NIDEK AFC-230 — 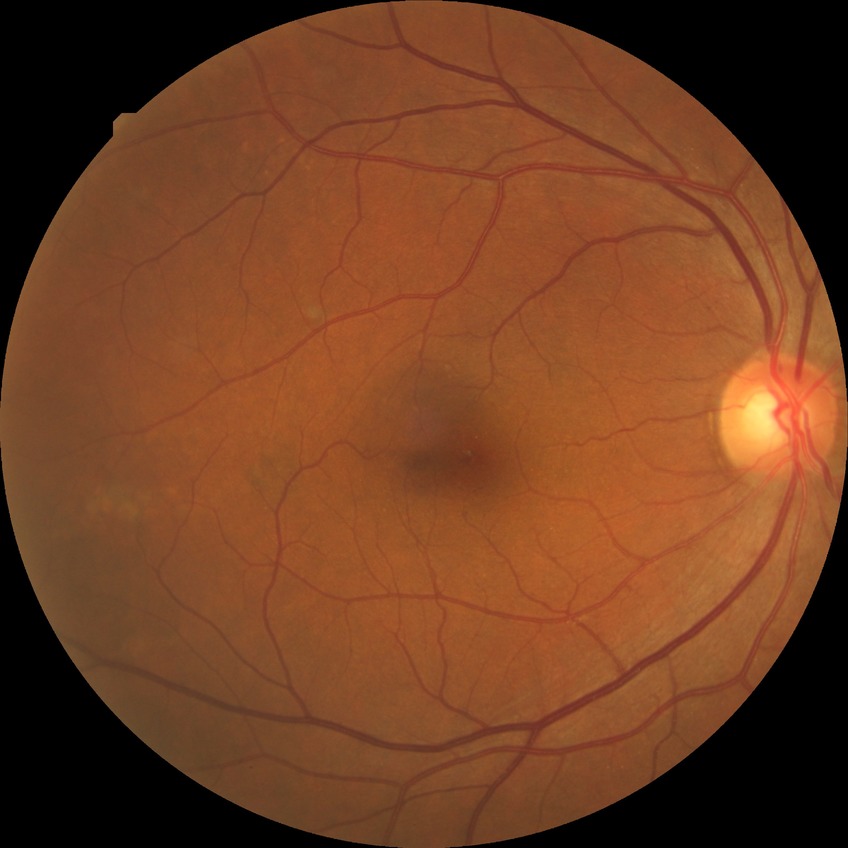

– diabetic retinopathy (DR): no diabetic retinopathy (NDR)